FOV: 45 degrees; 1470 x 1137 pixels; color fundus image: 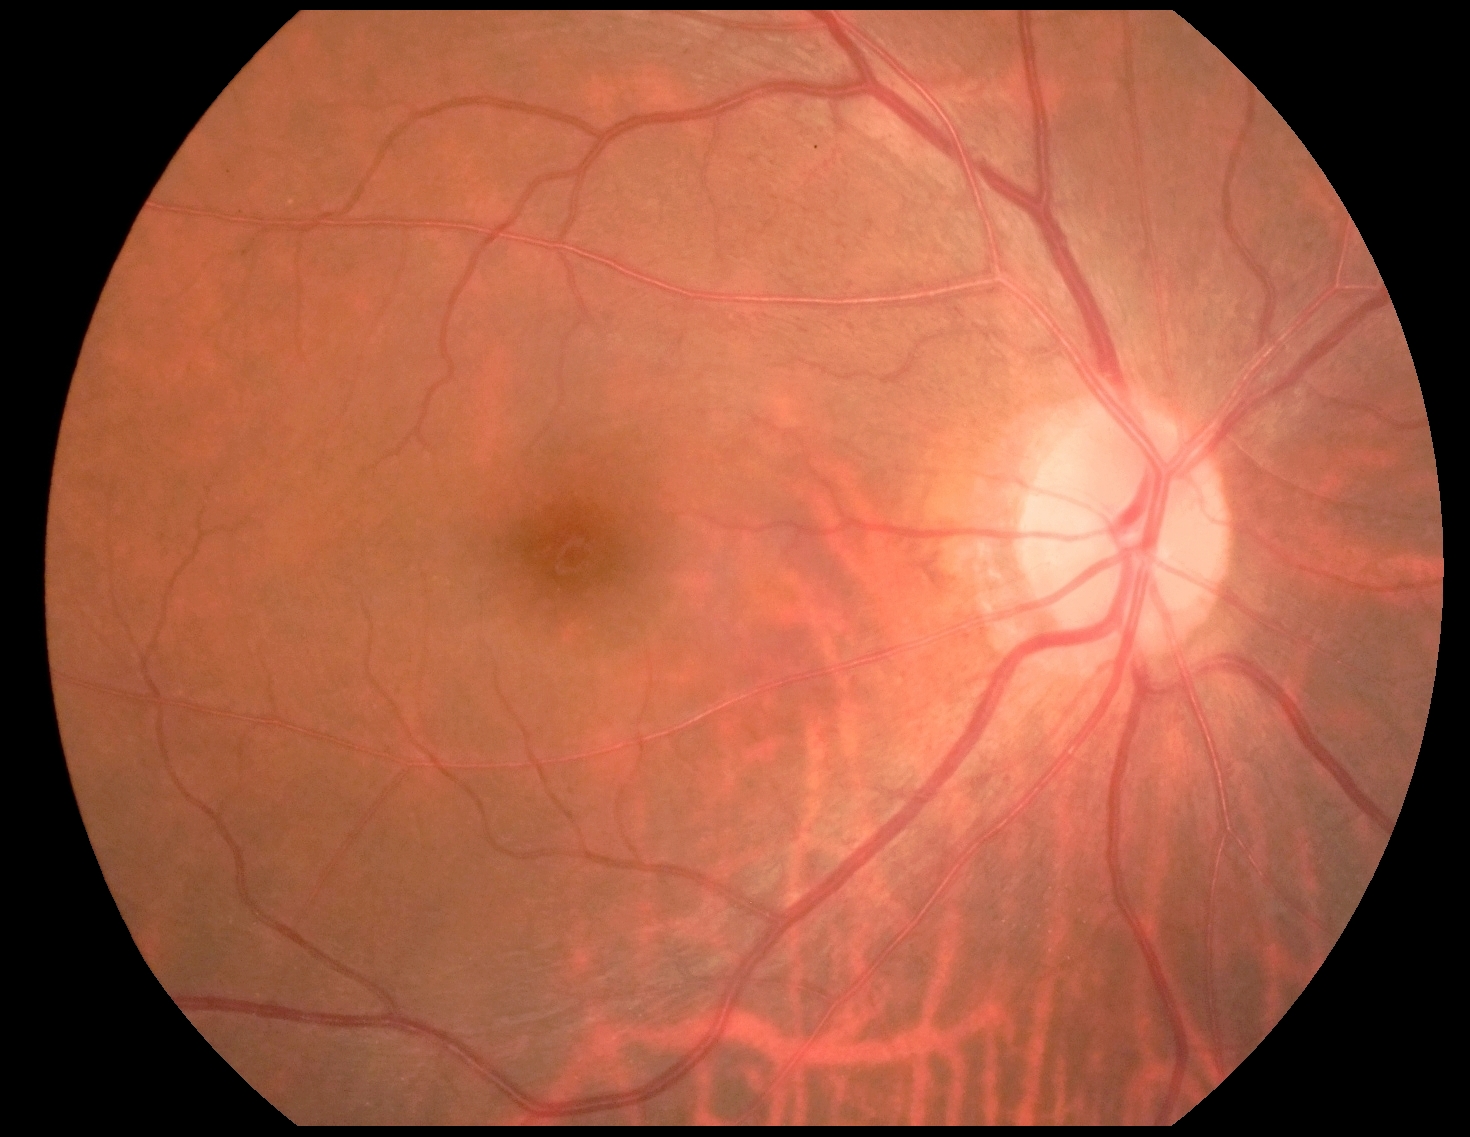 The retinopathy is classified as non-proliferative diabetic retinopathy. DR severity: 1/4 — presence of microaneurysms only.